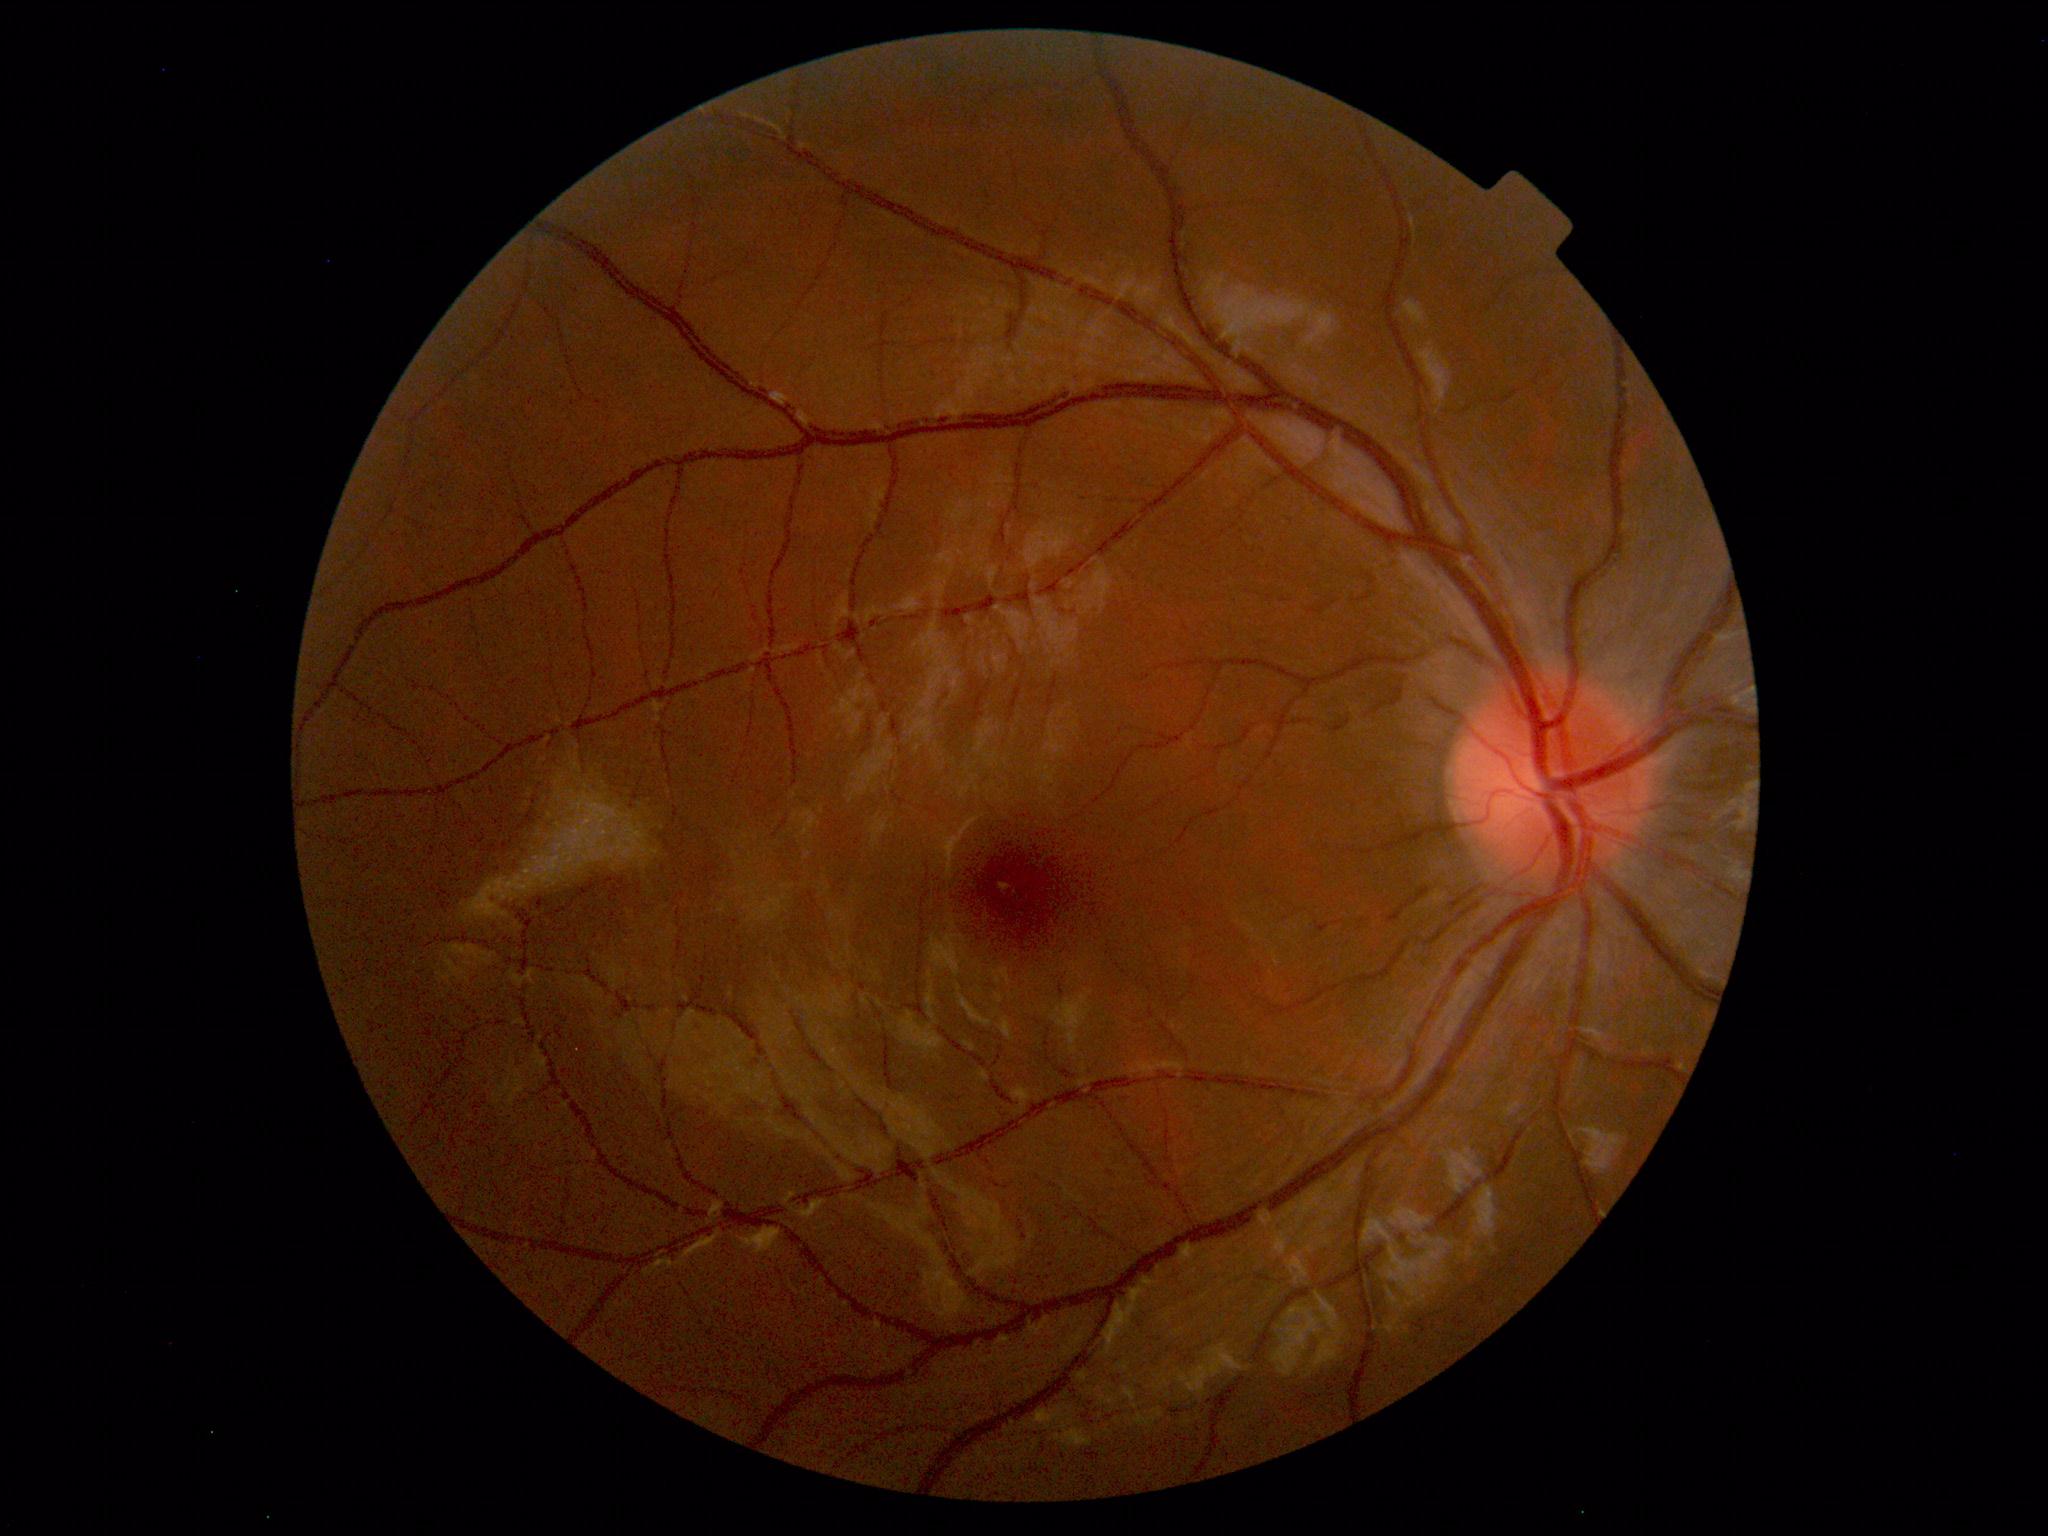 Impression: within normal limits.